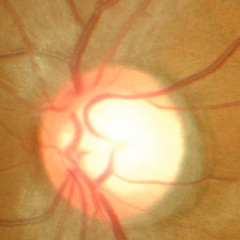

Optic nerve head appearance consistent with no glaucomatous changes.